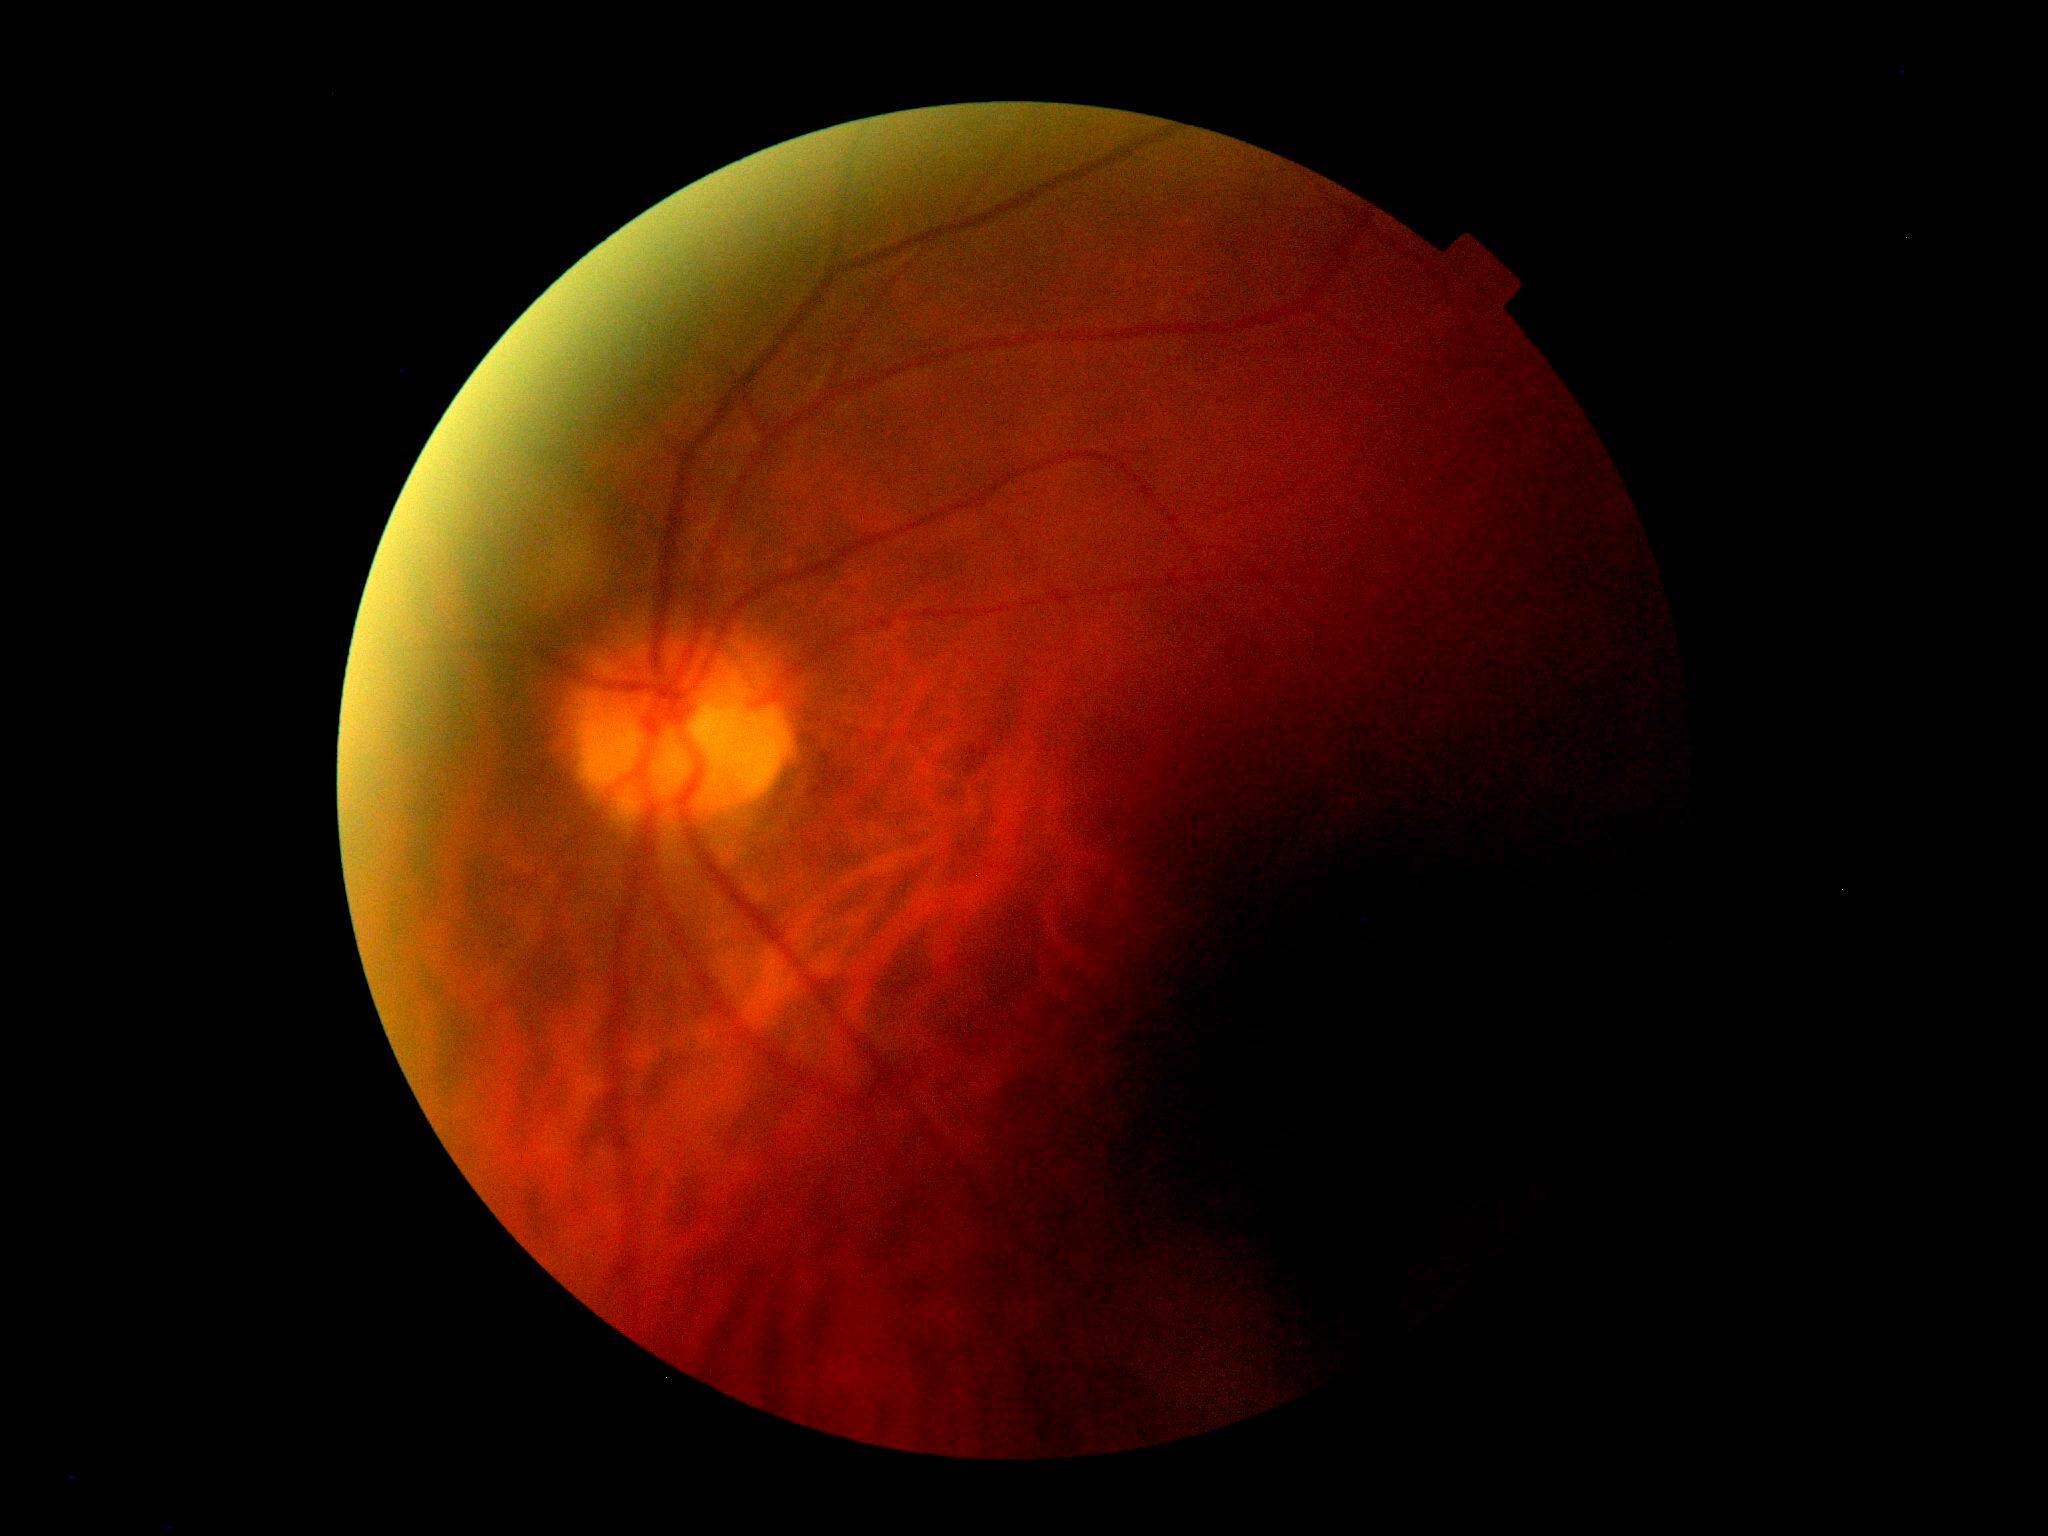 Quality too poor to assess for DR. DR grade: ungradable.